DR severity per modified Davis staging: 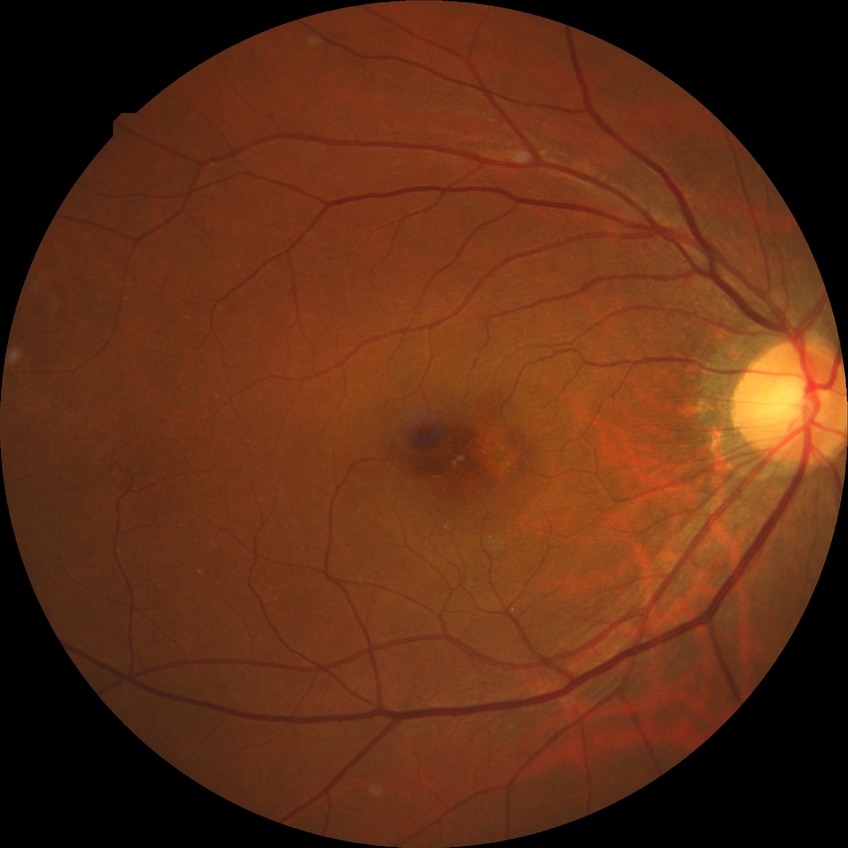
DR stage is NDR. No diabetic retinal disease findings.